Color fundus image; FOV: 45 degrees; NIDEK AFC-230; nonmydriatic fundus photograph.
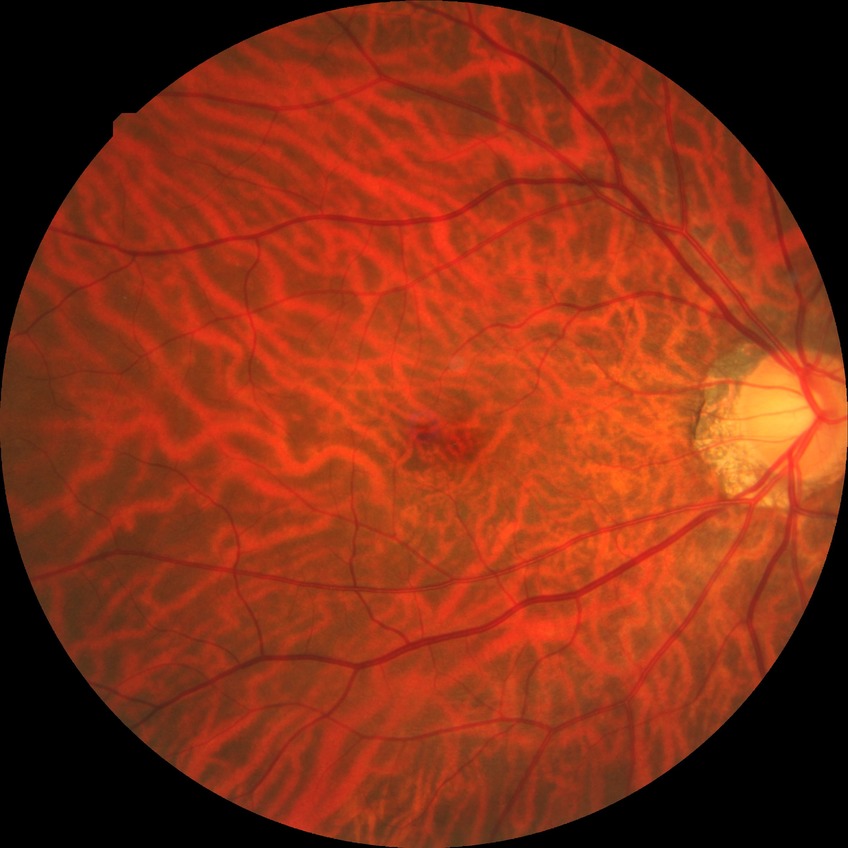
Findings:
– modified Davis grading: no diabetic retinopathy